Color fundus photograph: 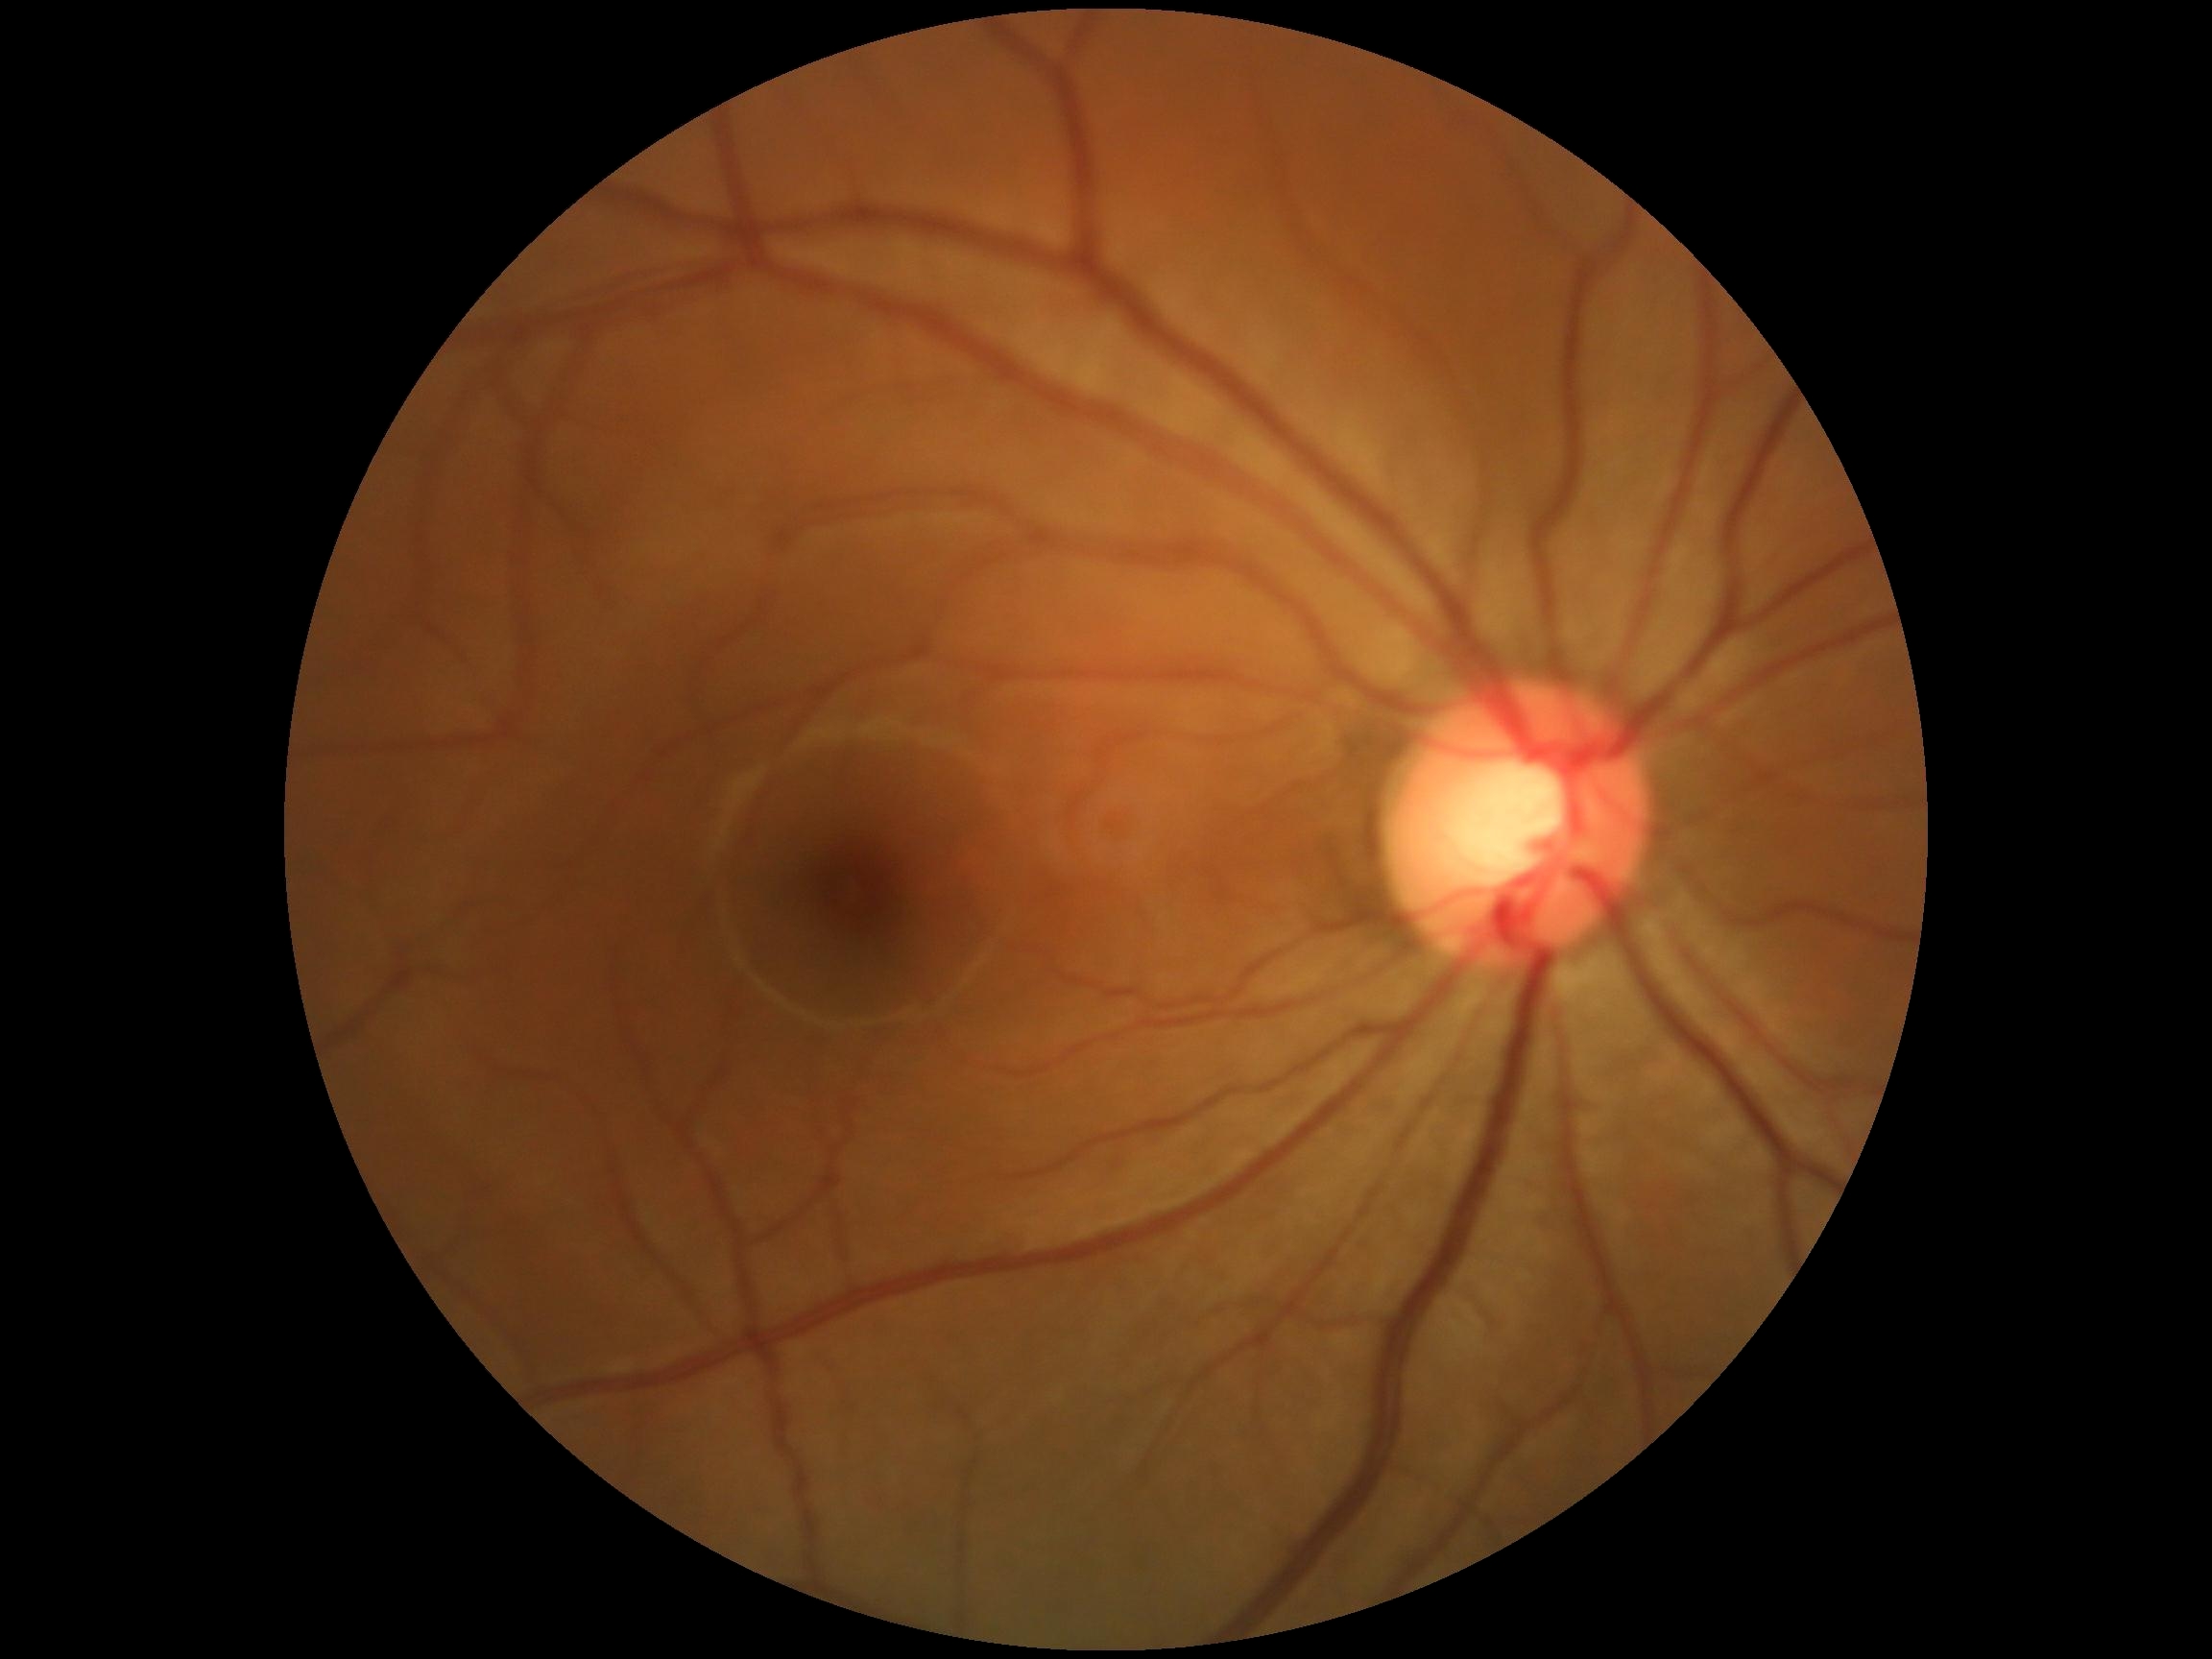 Findings:
* DR grade — 0 — no visible signs of diabetic retinopathy